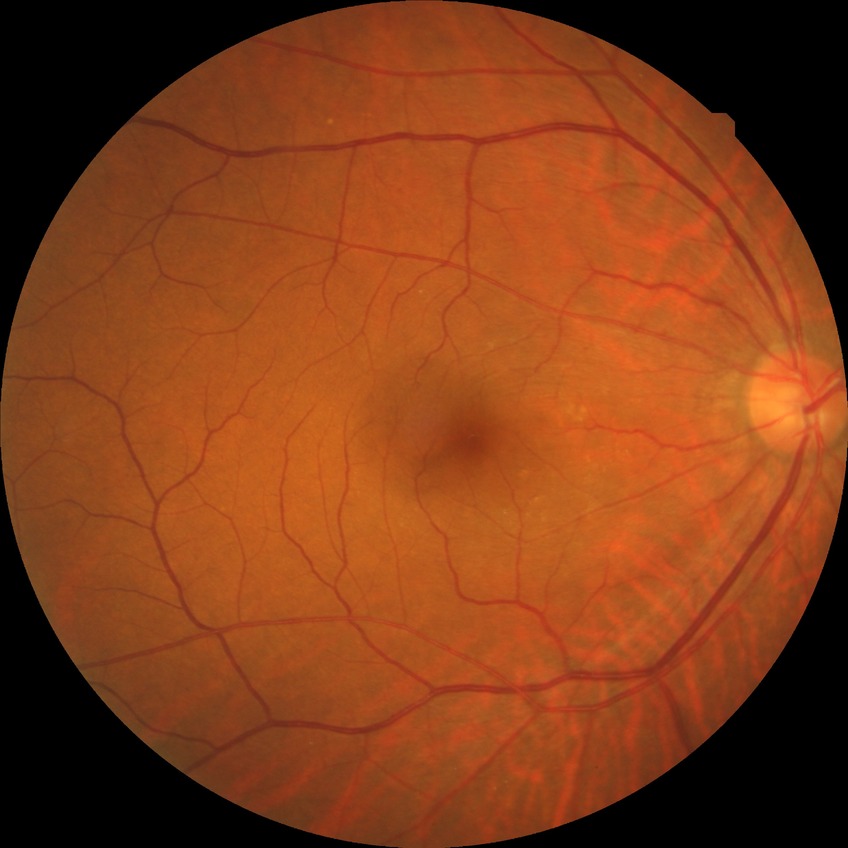
diabetic retinopathy (DR): NDR (no diabetic retinopathy)